FOV: 45 degrees, NIDEK AFC-230 fundus camera.
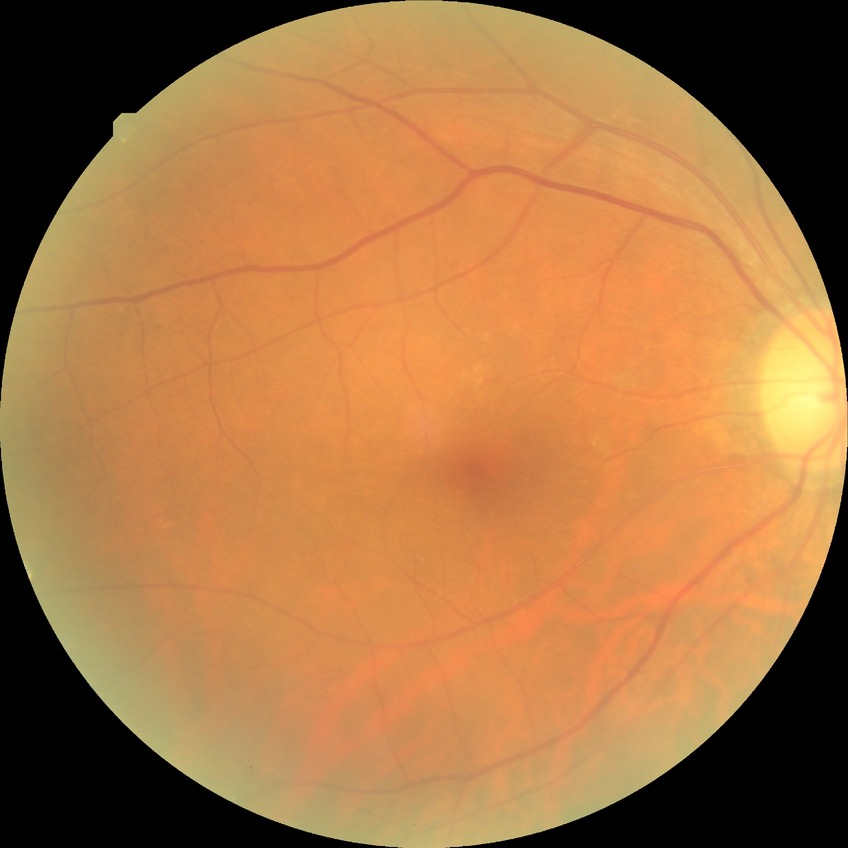 davis_grade: no diabetic retinopathy (NDR)